Retinal fundus photograph, 2352x1568px.
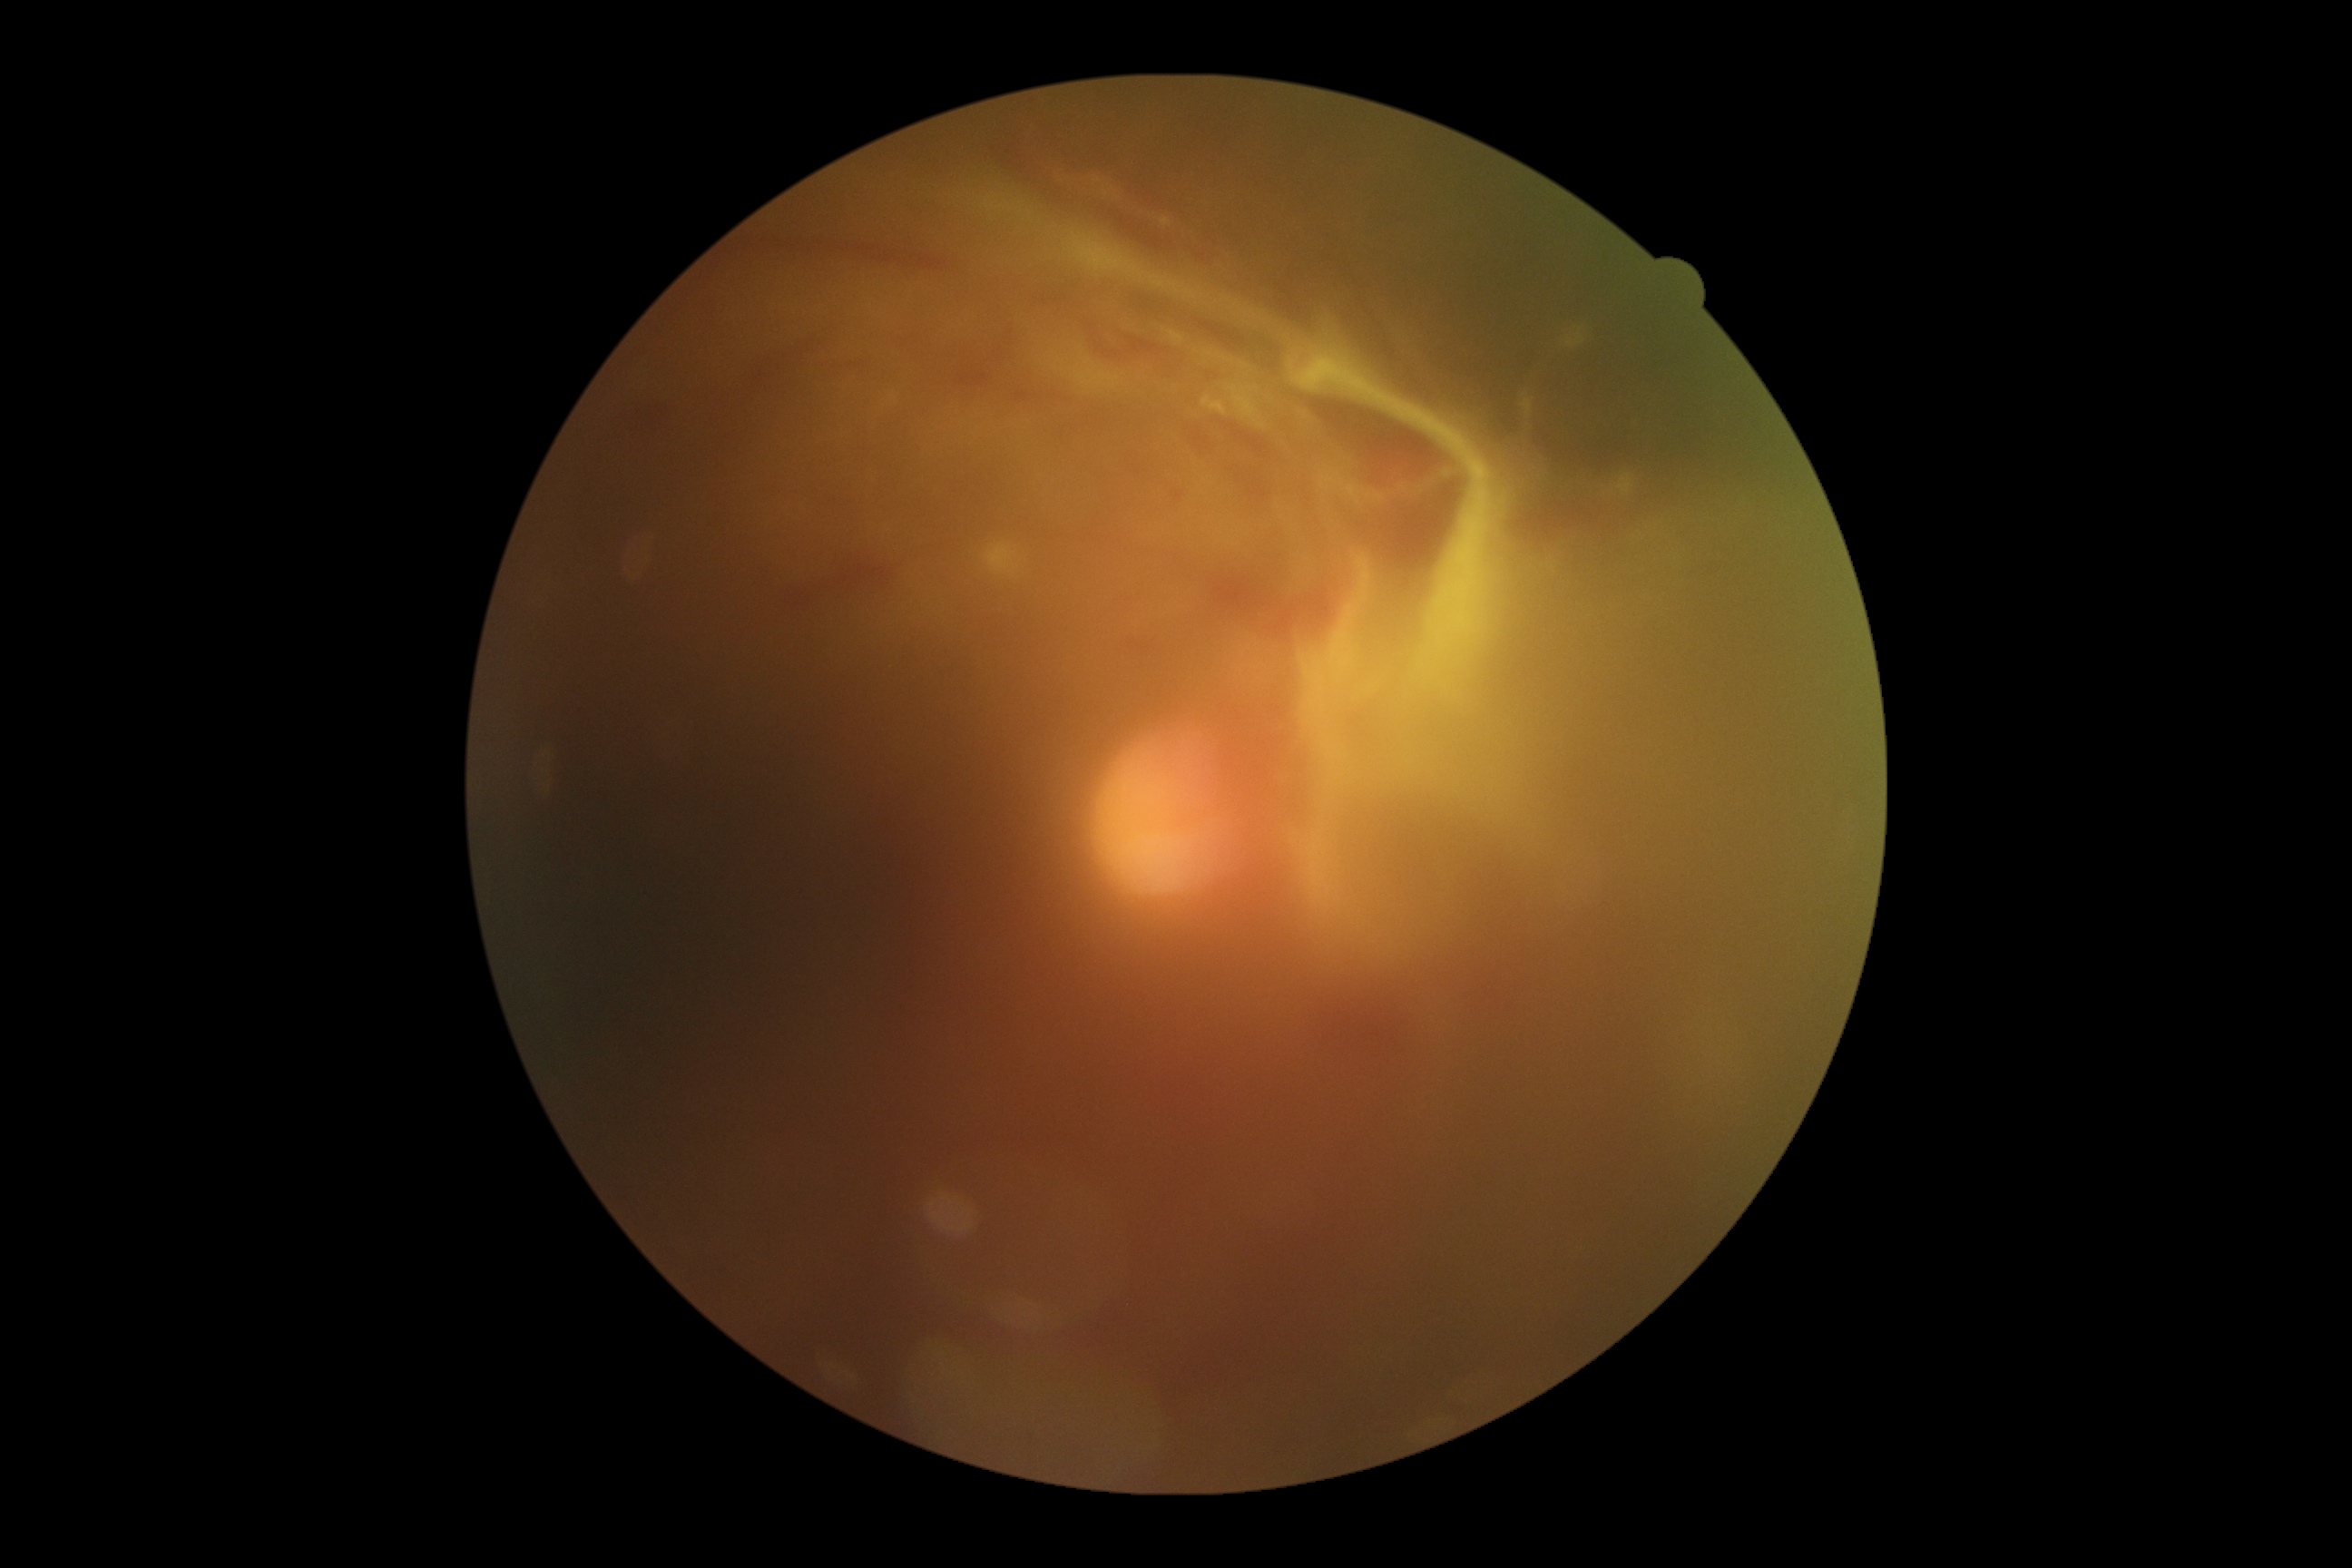

Disease class: proliferative diabetic retinopathy.
DR severity: grade 4.